100° field of view (Phoenix ICON); infant wide-field fundus photograph — 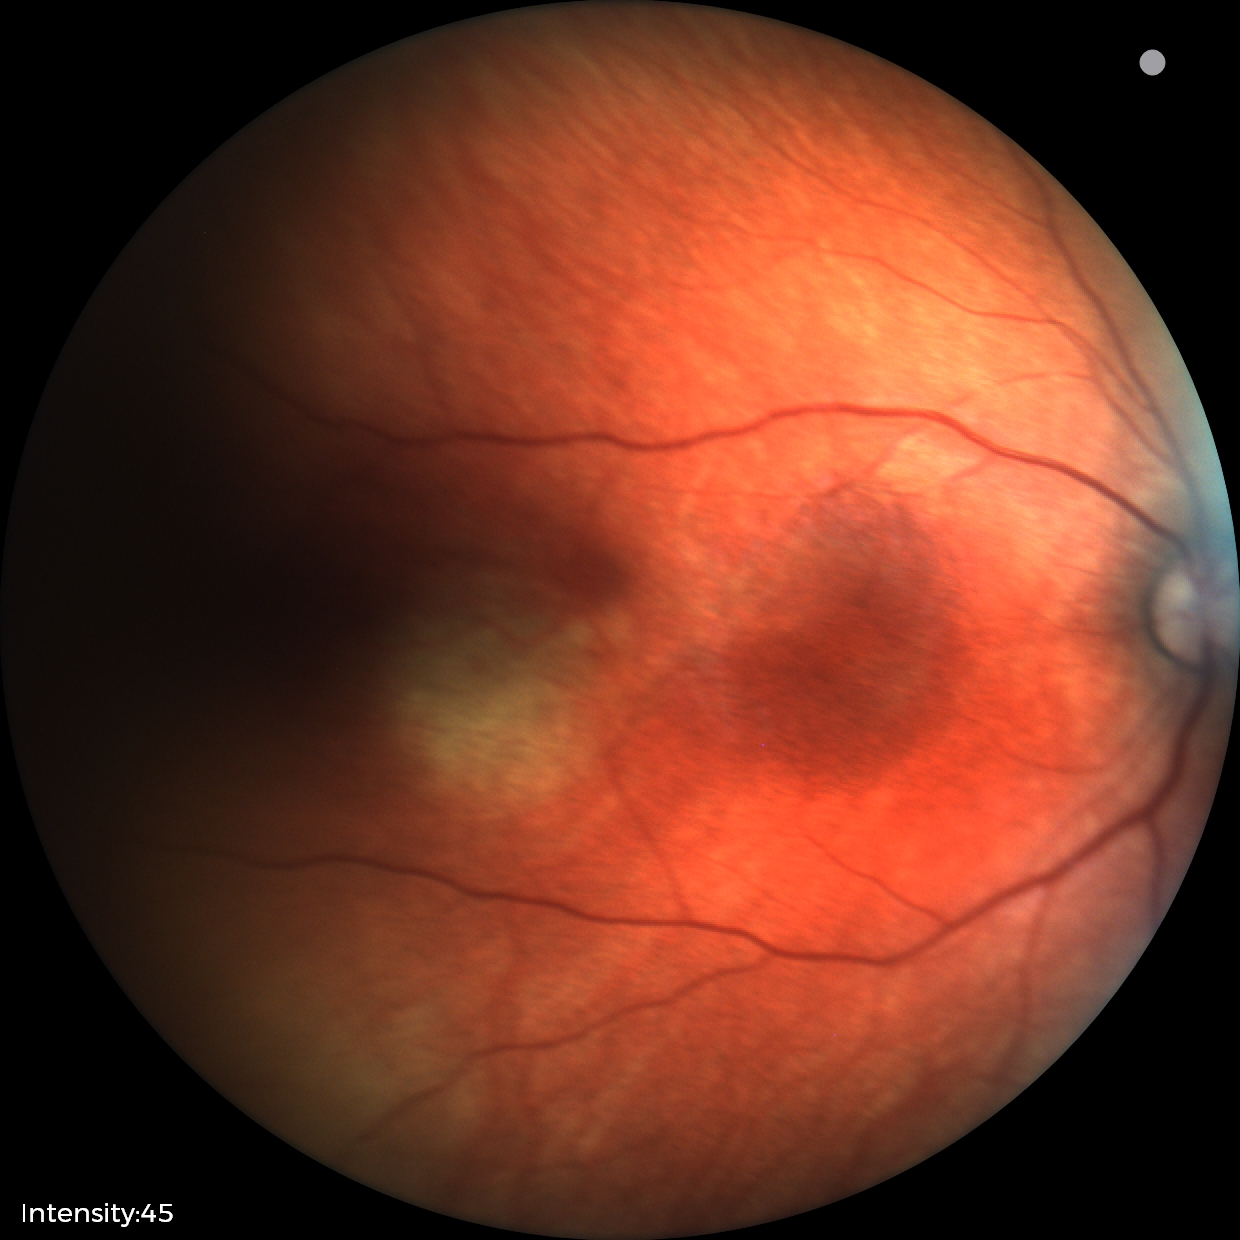 Screening: normal fundus examination.